2352 by 1568 pixels. CFP.
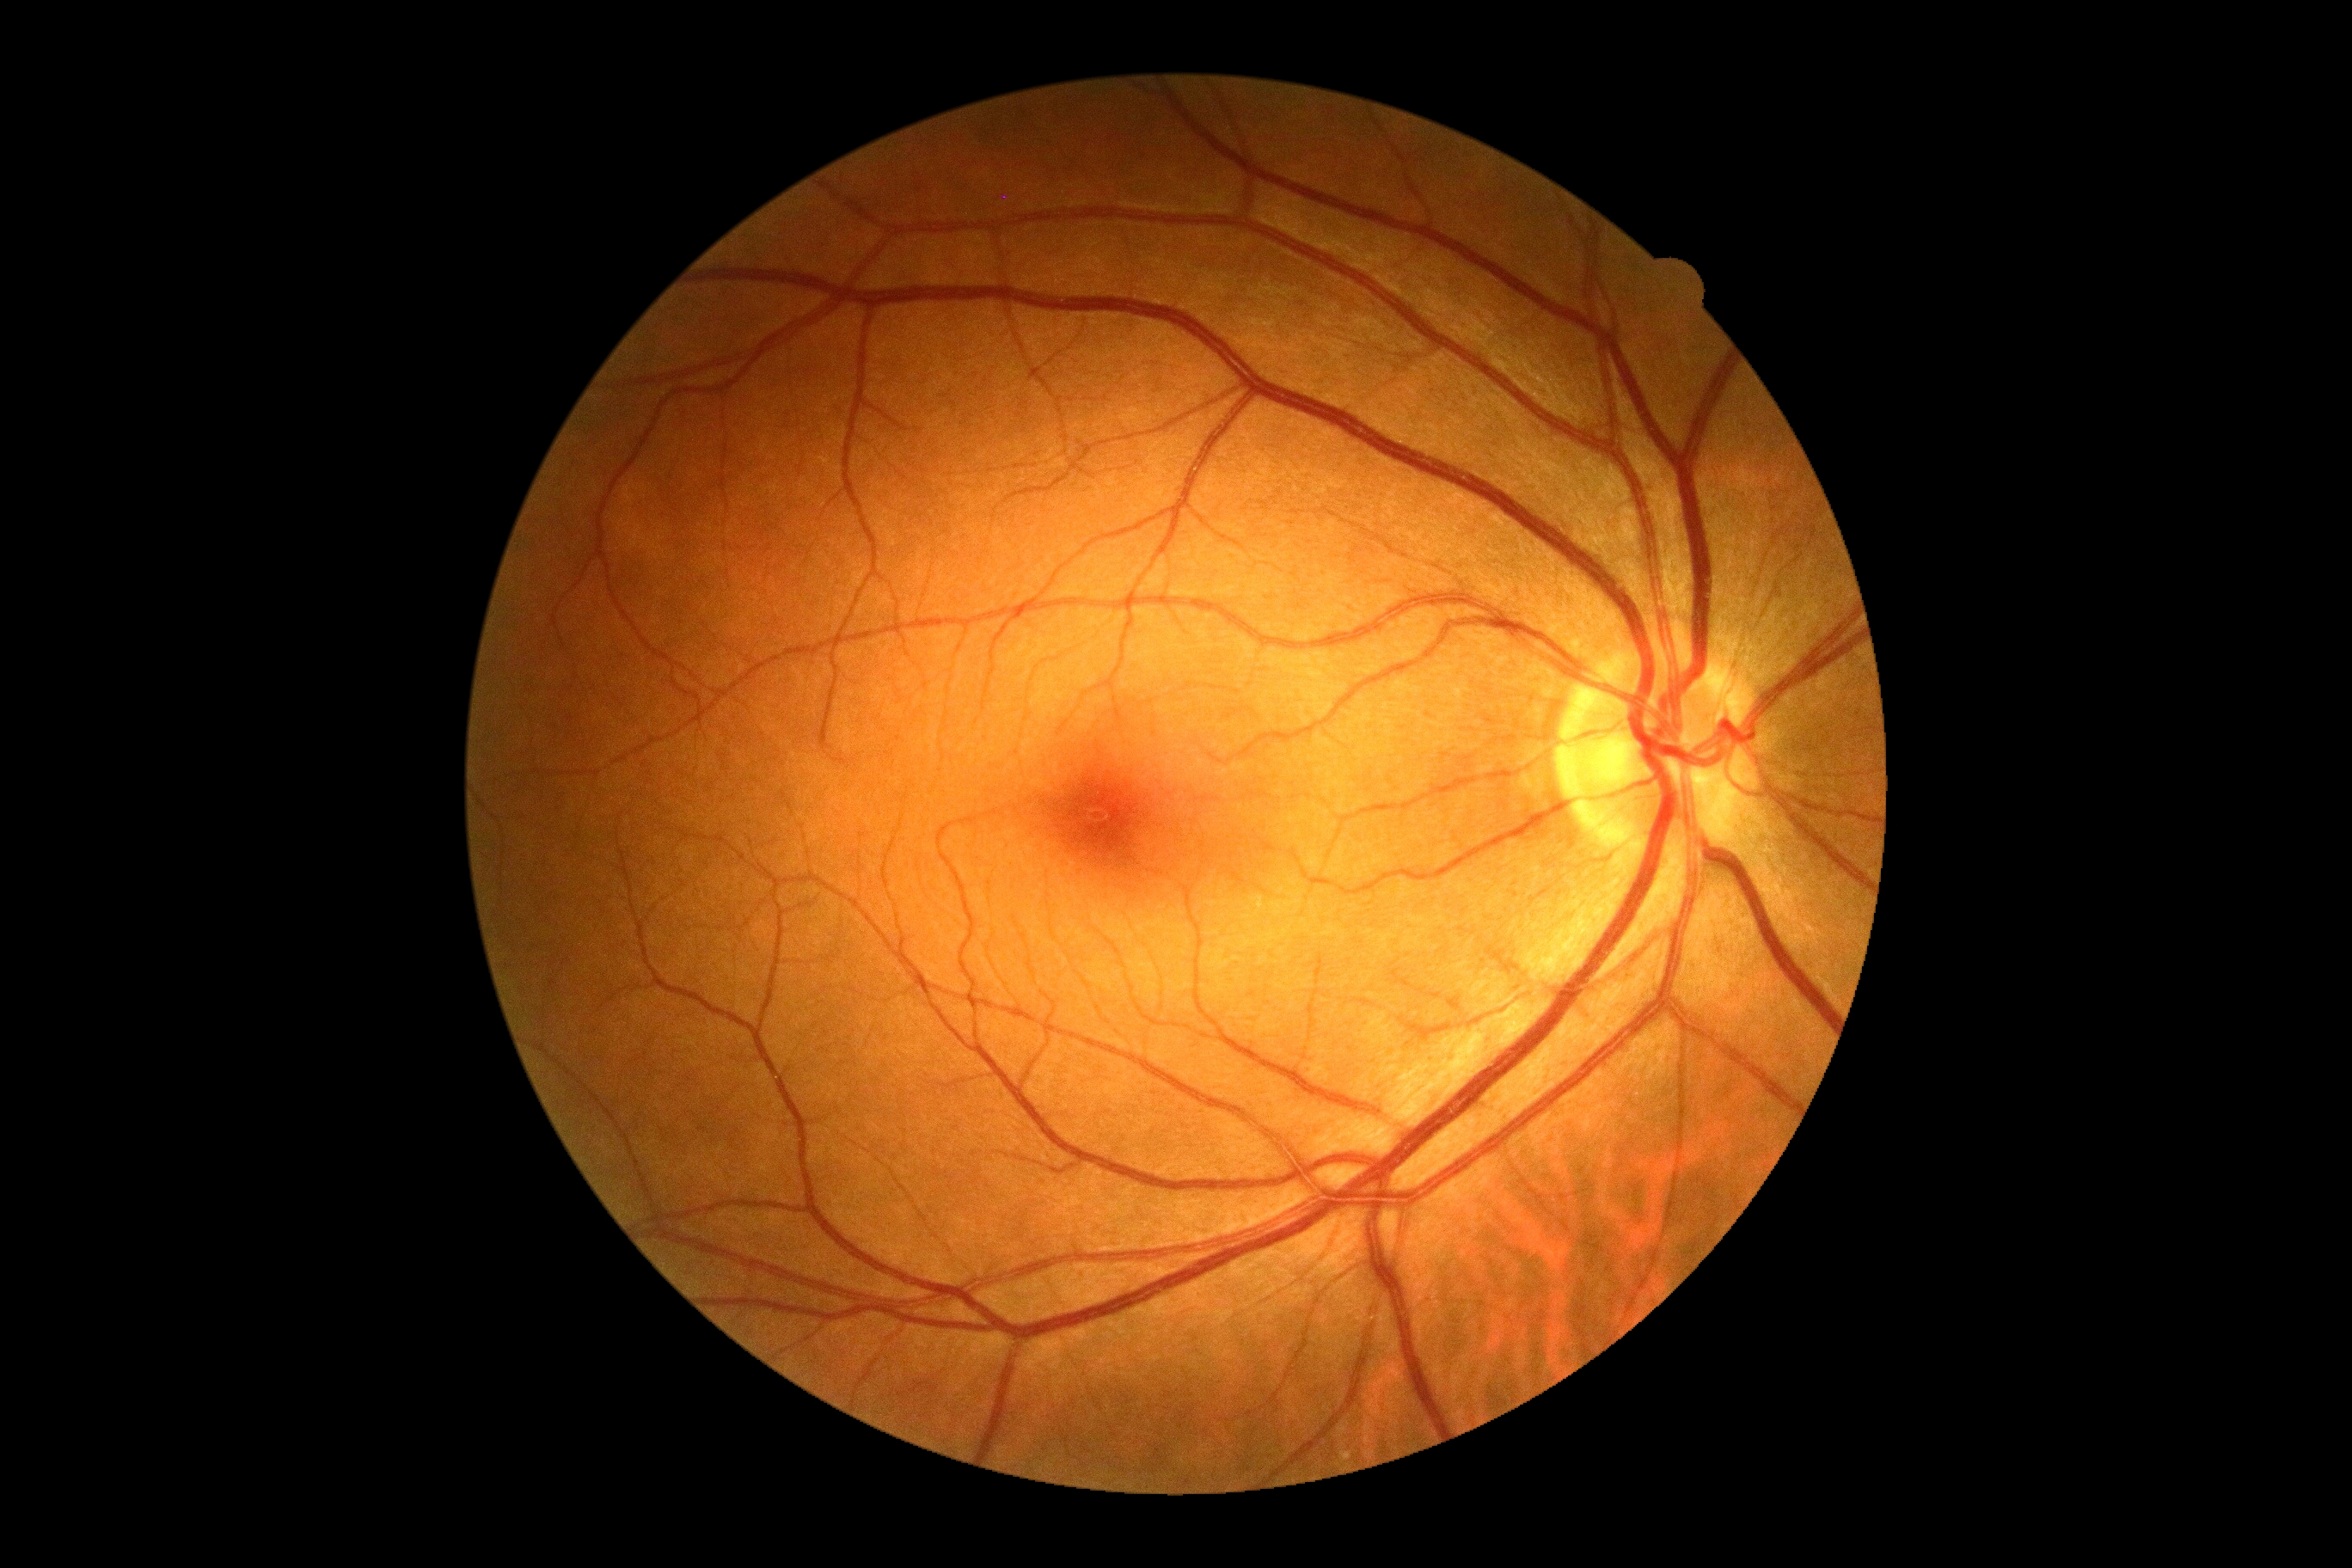
DR impression: negative for DR; retinopathy: 0/4 — no visible signs of diabetic retinopathy.